45° field of view; retinal fundus photograph
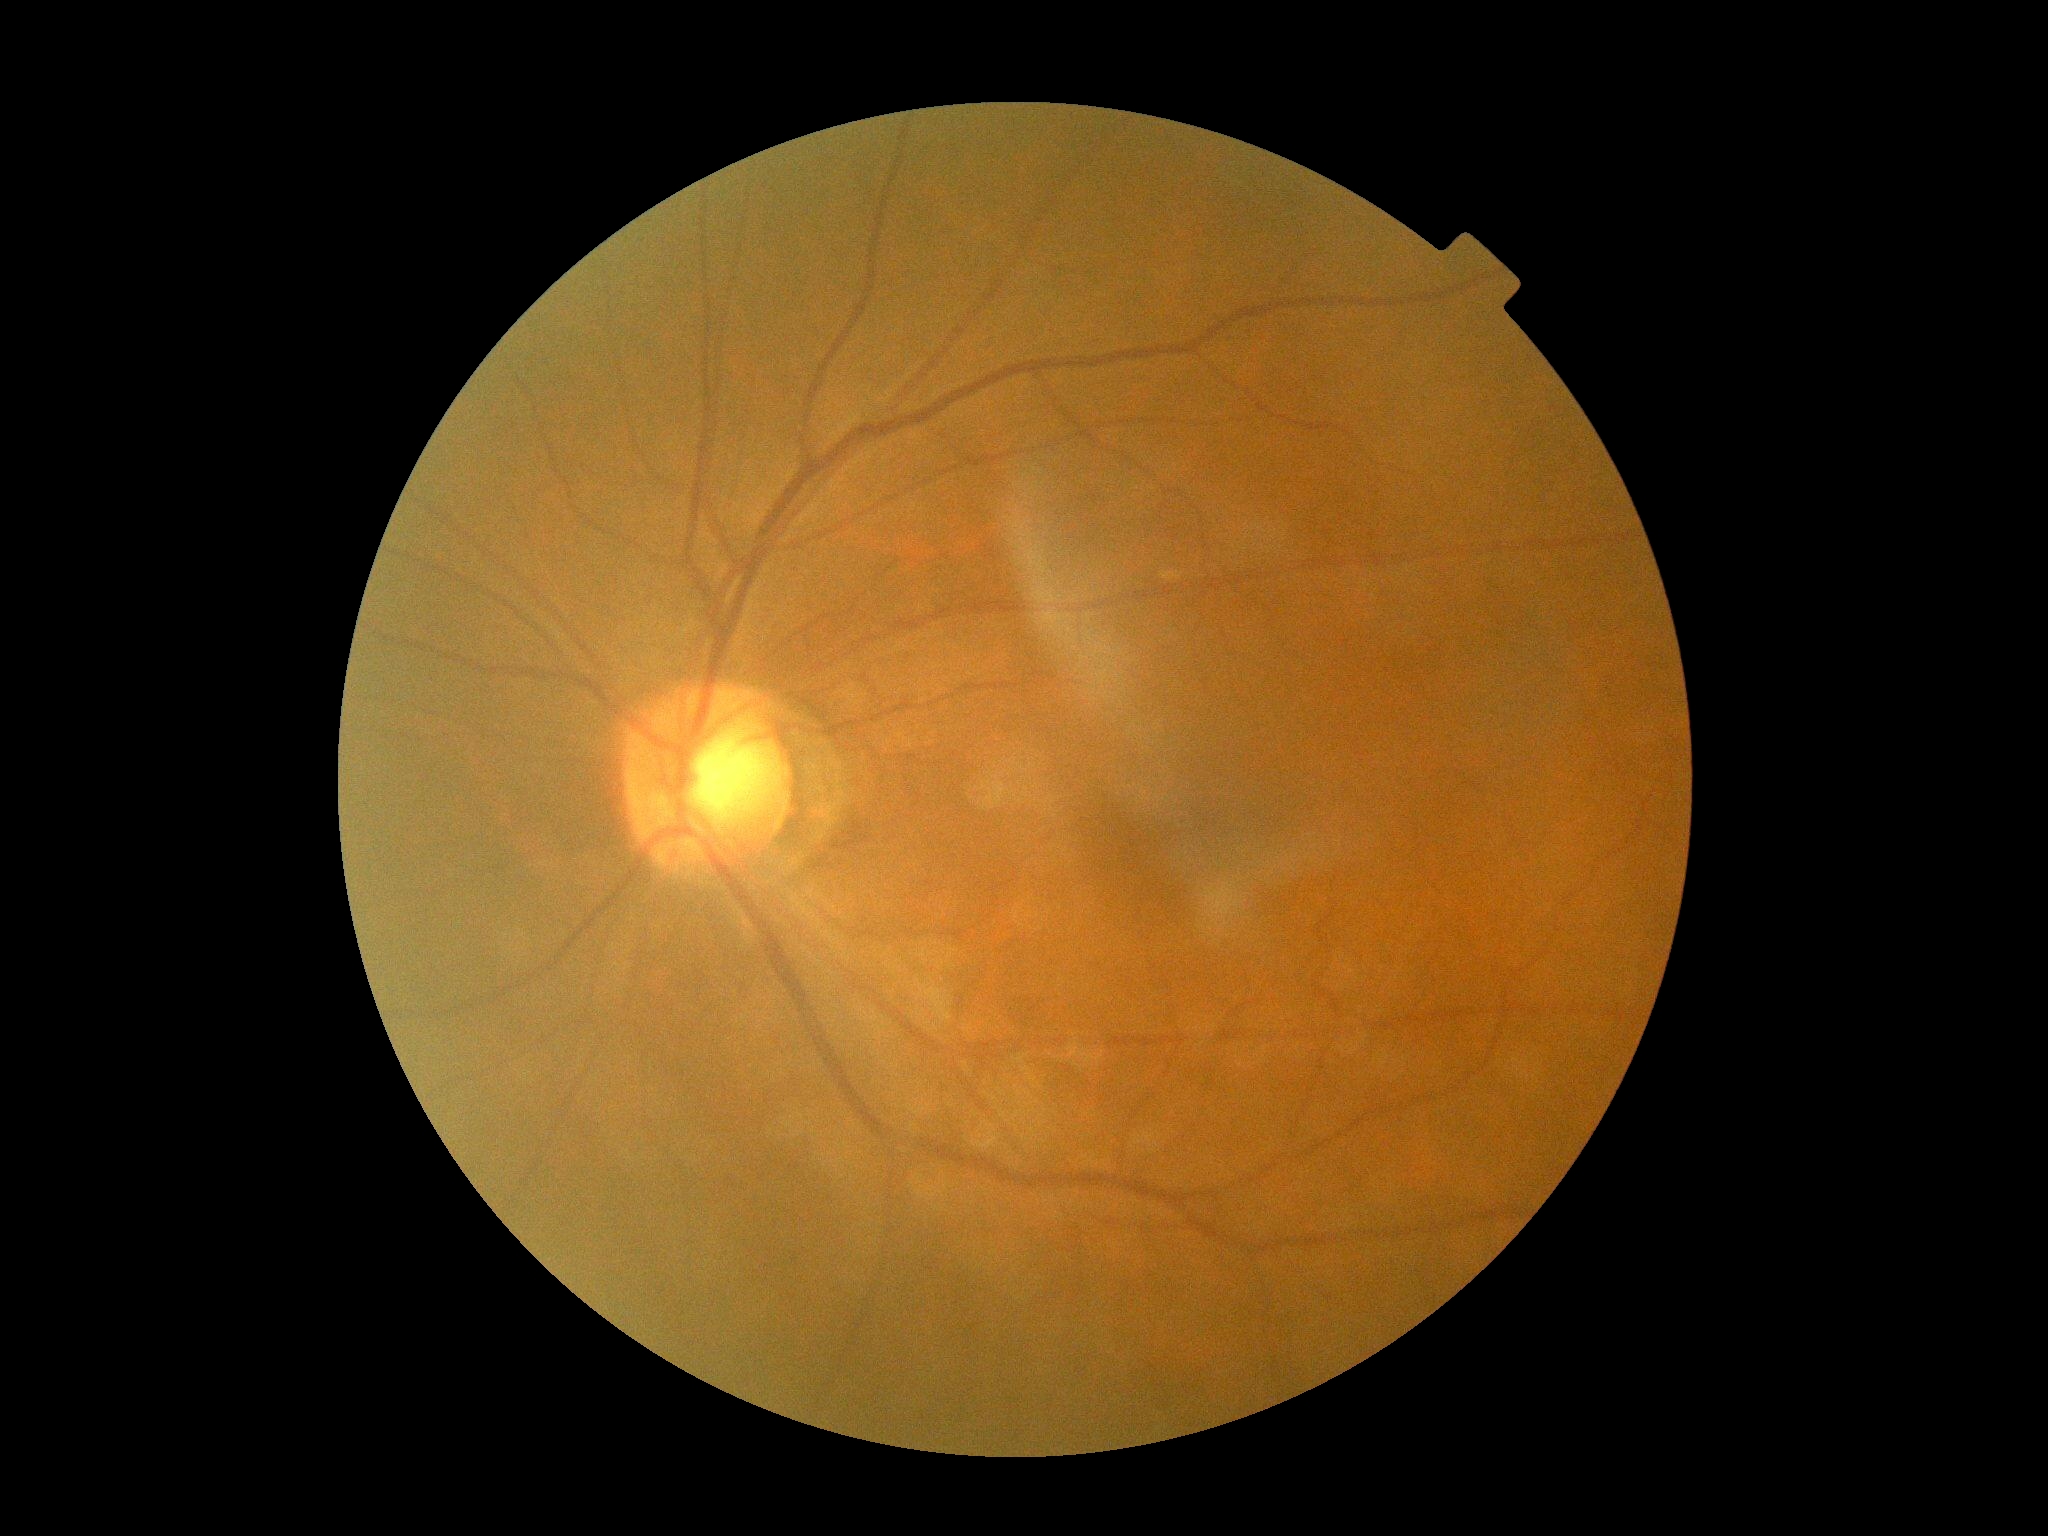

Diabetic retinopathy (DR) is grade 0 (no apparent retinopathy).